Image size 1240x1240. Captured with the Phoenix ICON (100° field of view). Wide-field fundus image from infant ROP screening:
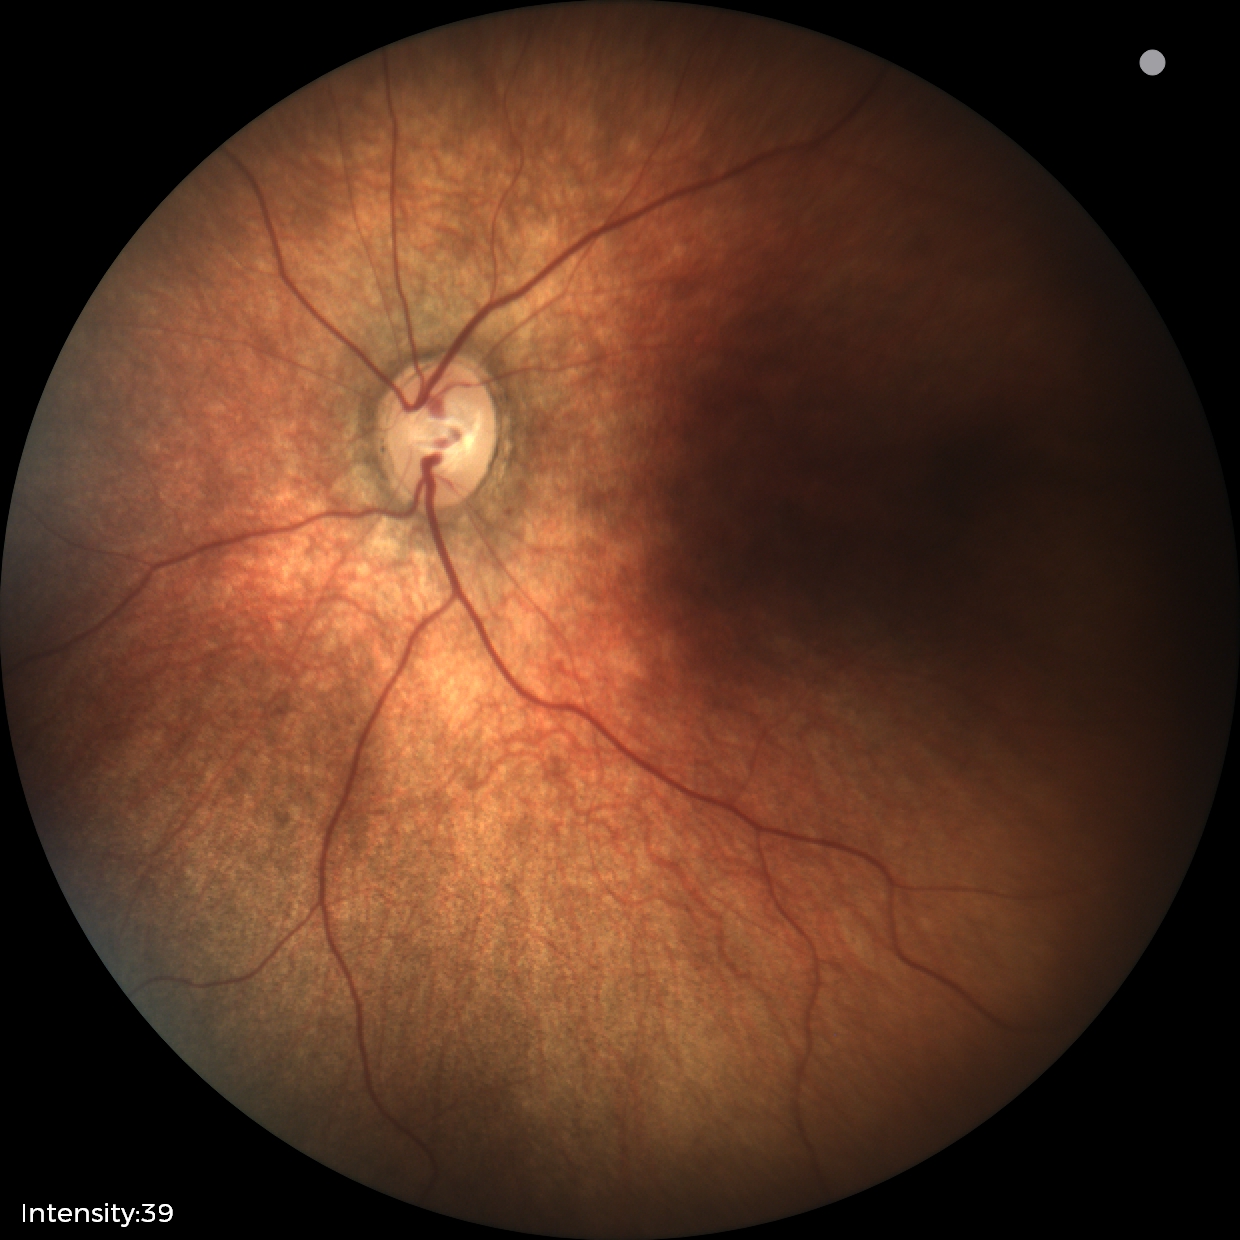 Diagnosis: physiological.